Color fundus photograph. 45° FOV:
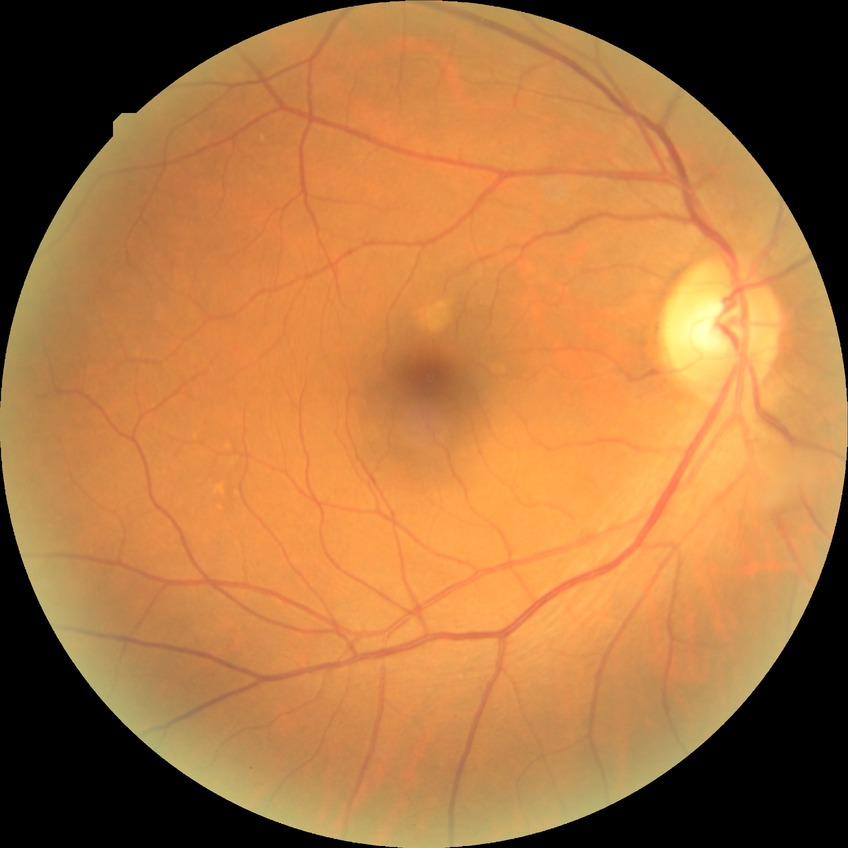

Retinopathy stage: no diabetic retinopathy.